Color fundus image
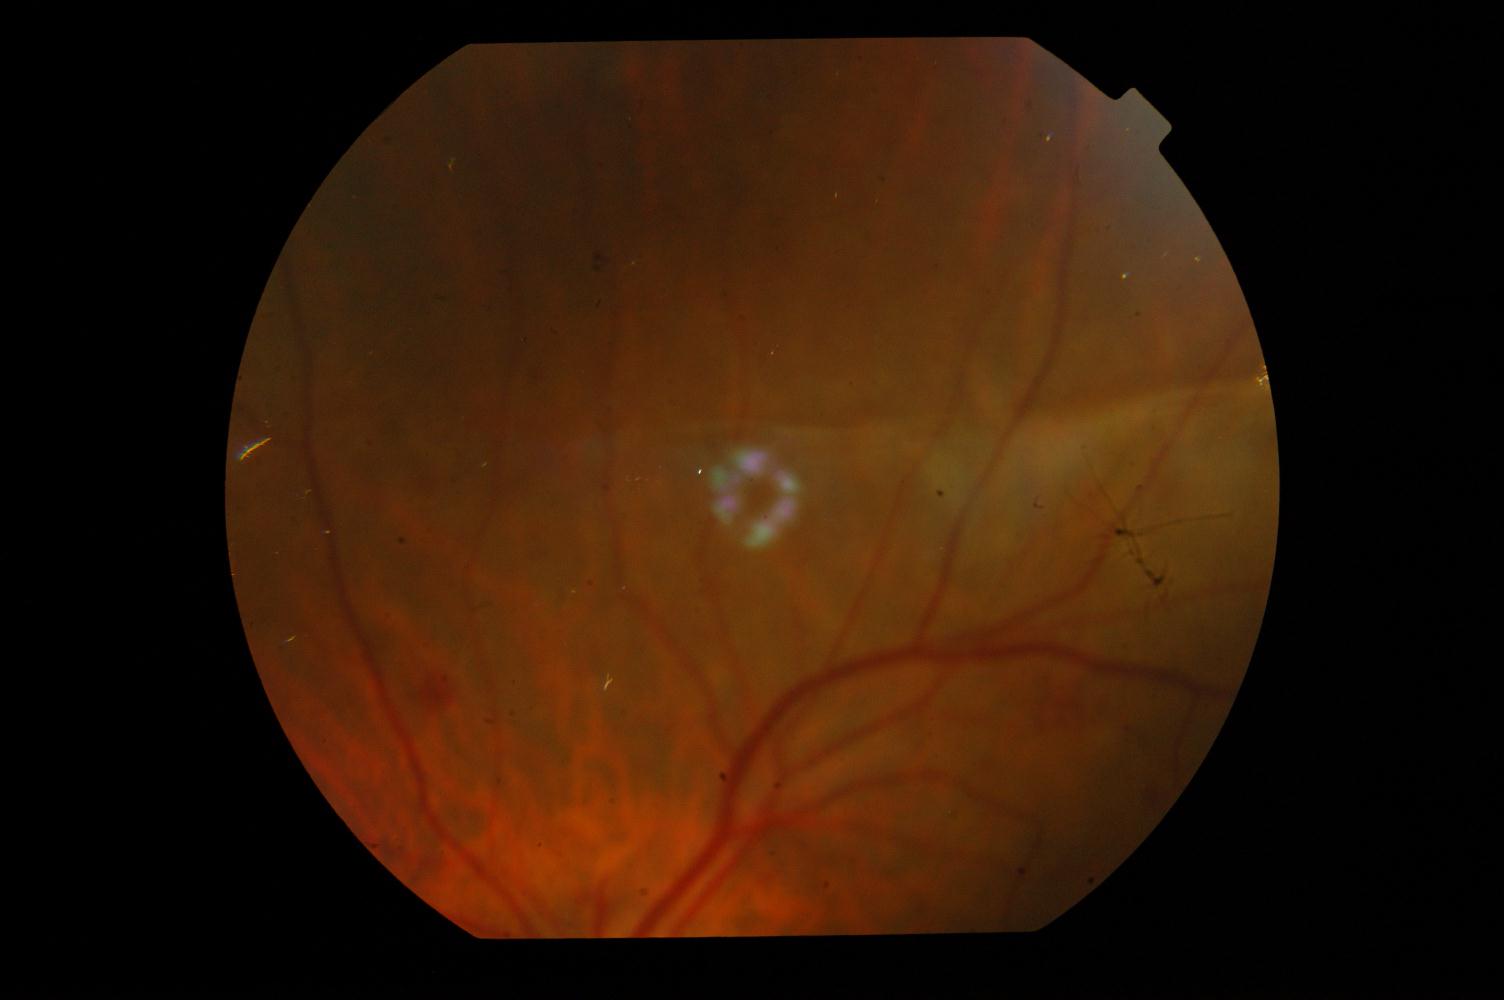 Demonstrates DR (diabetic retinopathy).